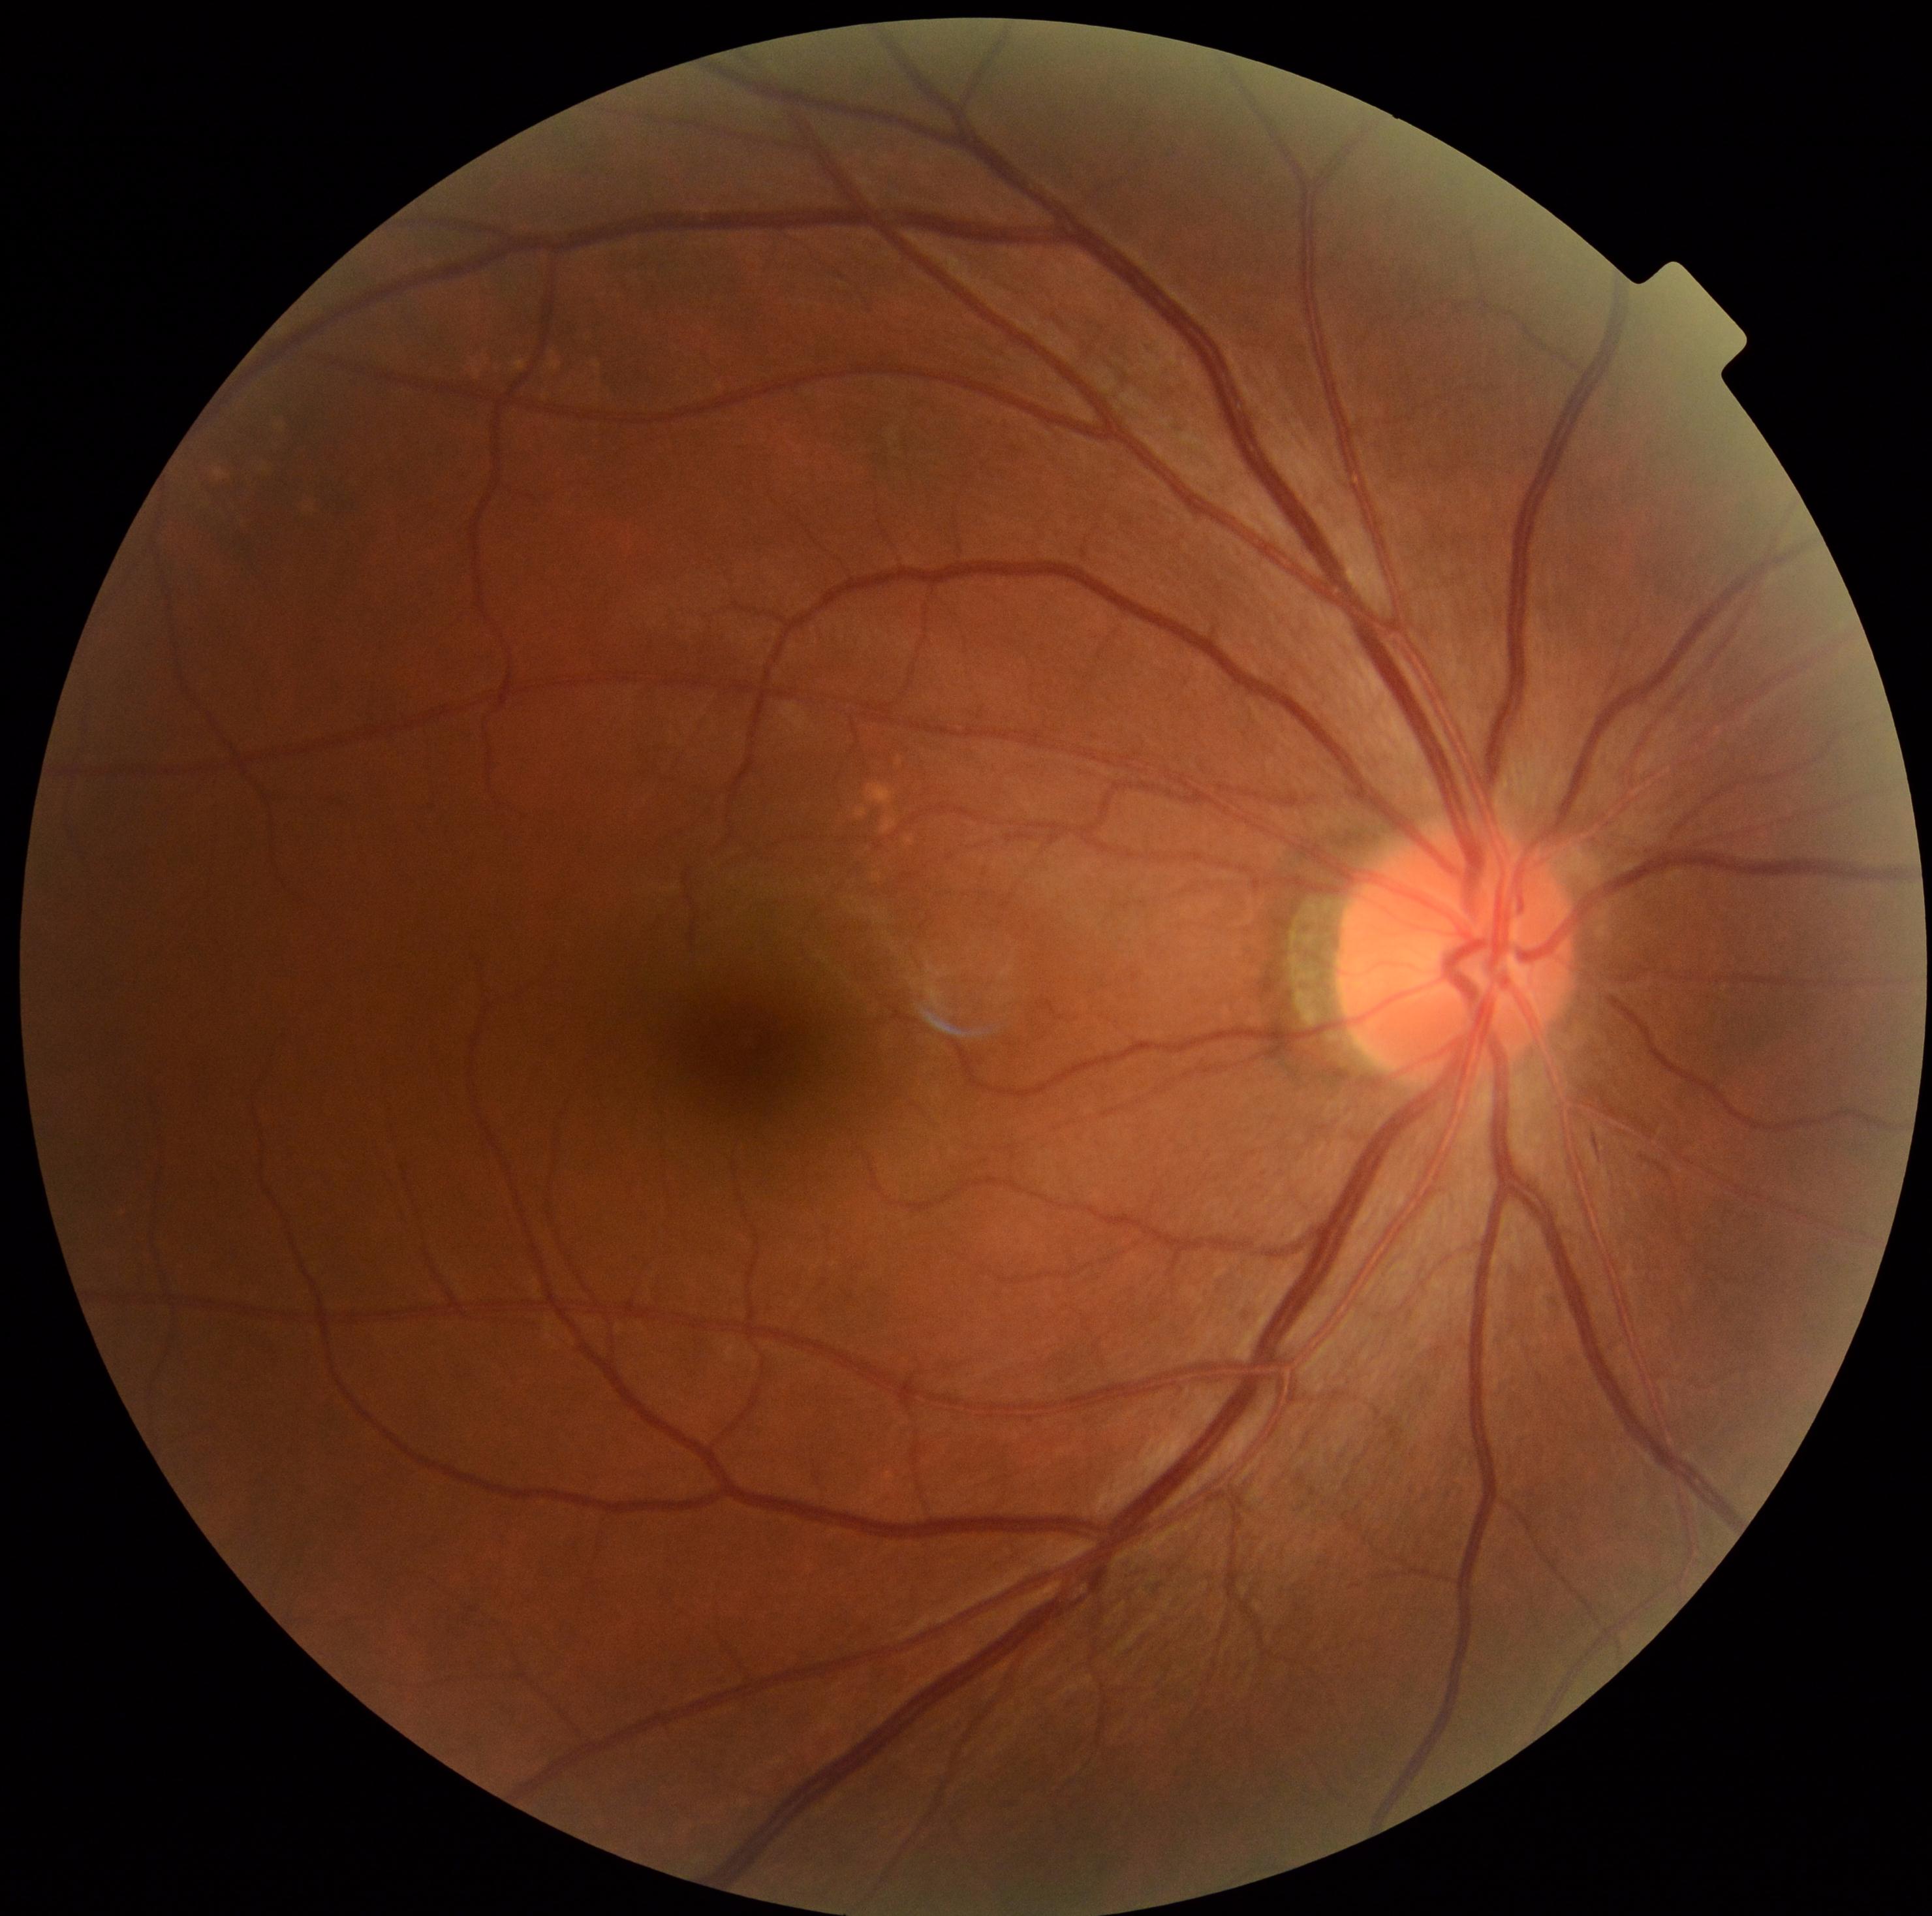 DR severity: no apparent diabetic retinopathy (grade 0). No DR findings.